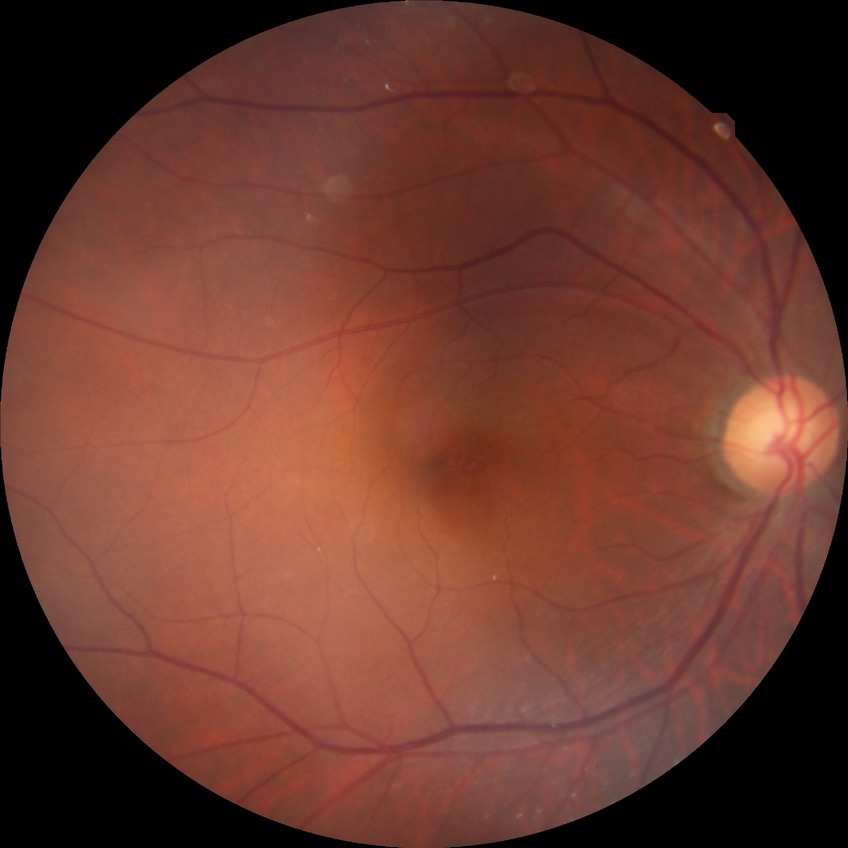

Diabetic retinopathy stage: no diabetic retinopathy.